Camera: Remidio smartphone fundus camera.
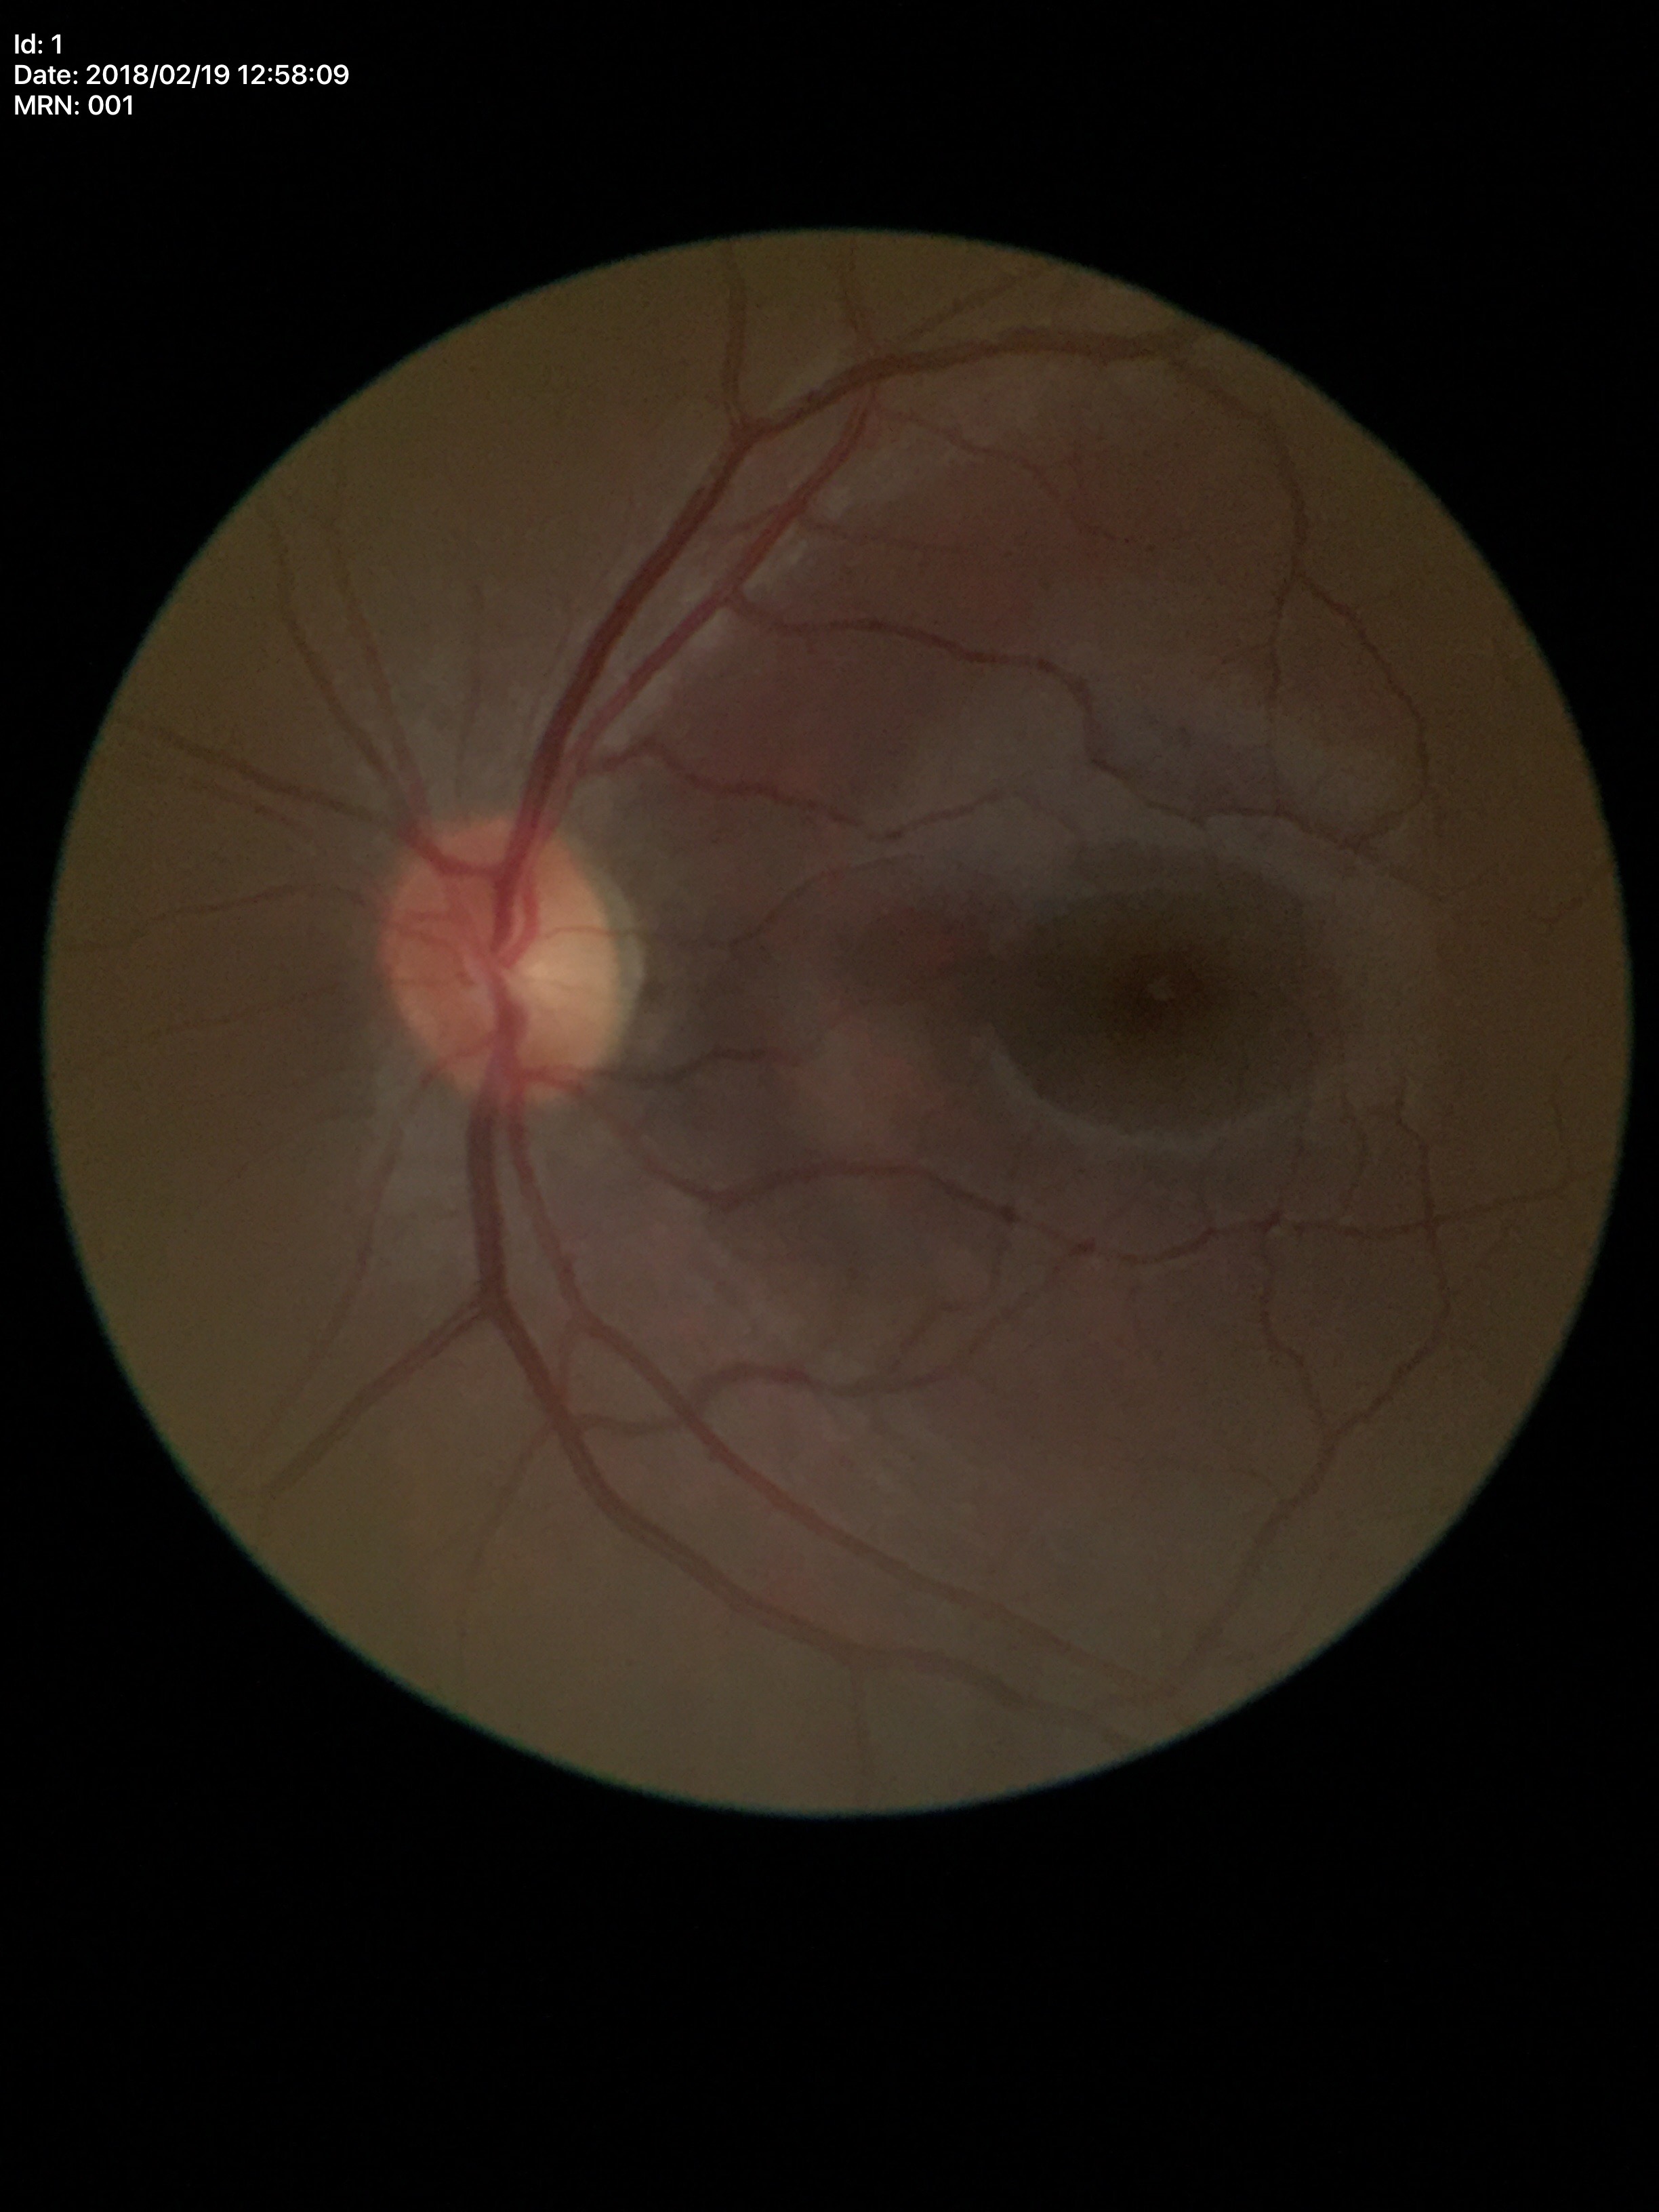

  vcdr: 0.46
  glaucoma_decision: no suspicious findings
  hcdr: 0.49